Color fundus image.
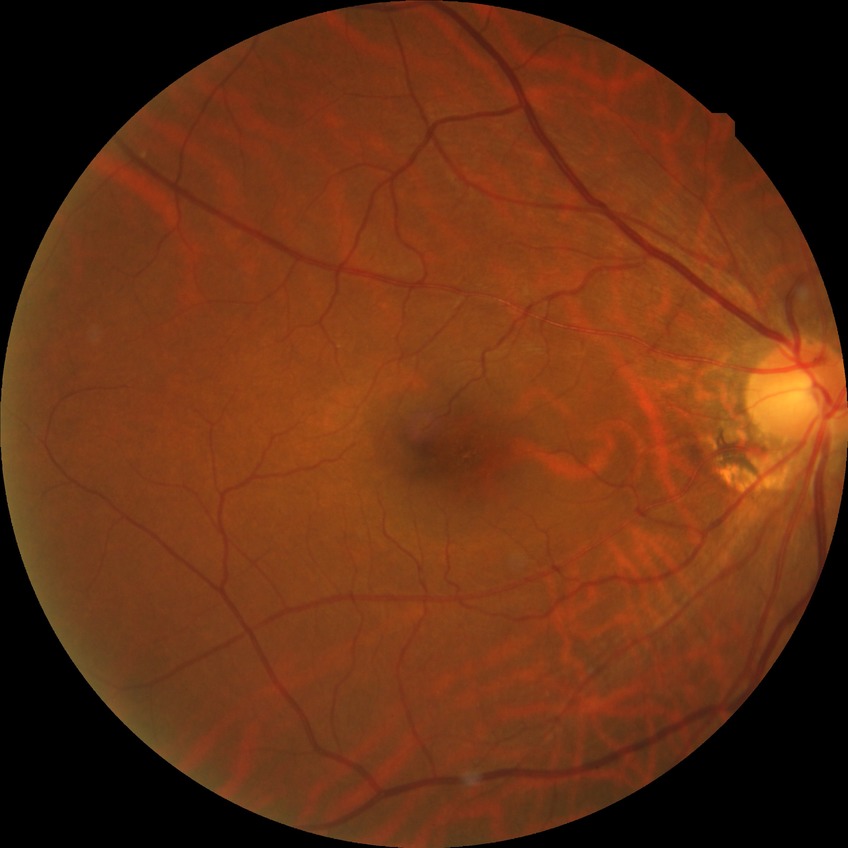 Findings:
* Davis grading: no diabetic retinopathy